RetCam wide-field infant fundus image; acquired on the Clarity RetCam 3:
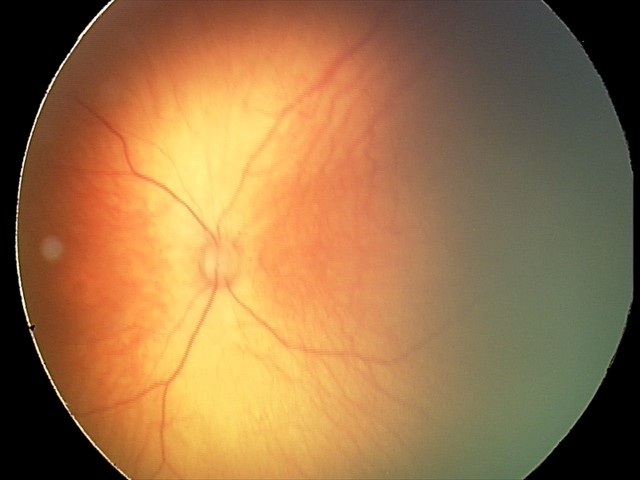 Screening diagnosis: no abnormal retinal findings.